Posterior pole view, 50-degree field of view, camera: Topcon TRC-50DX:
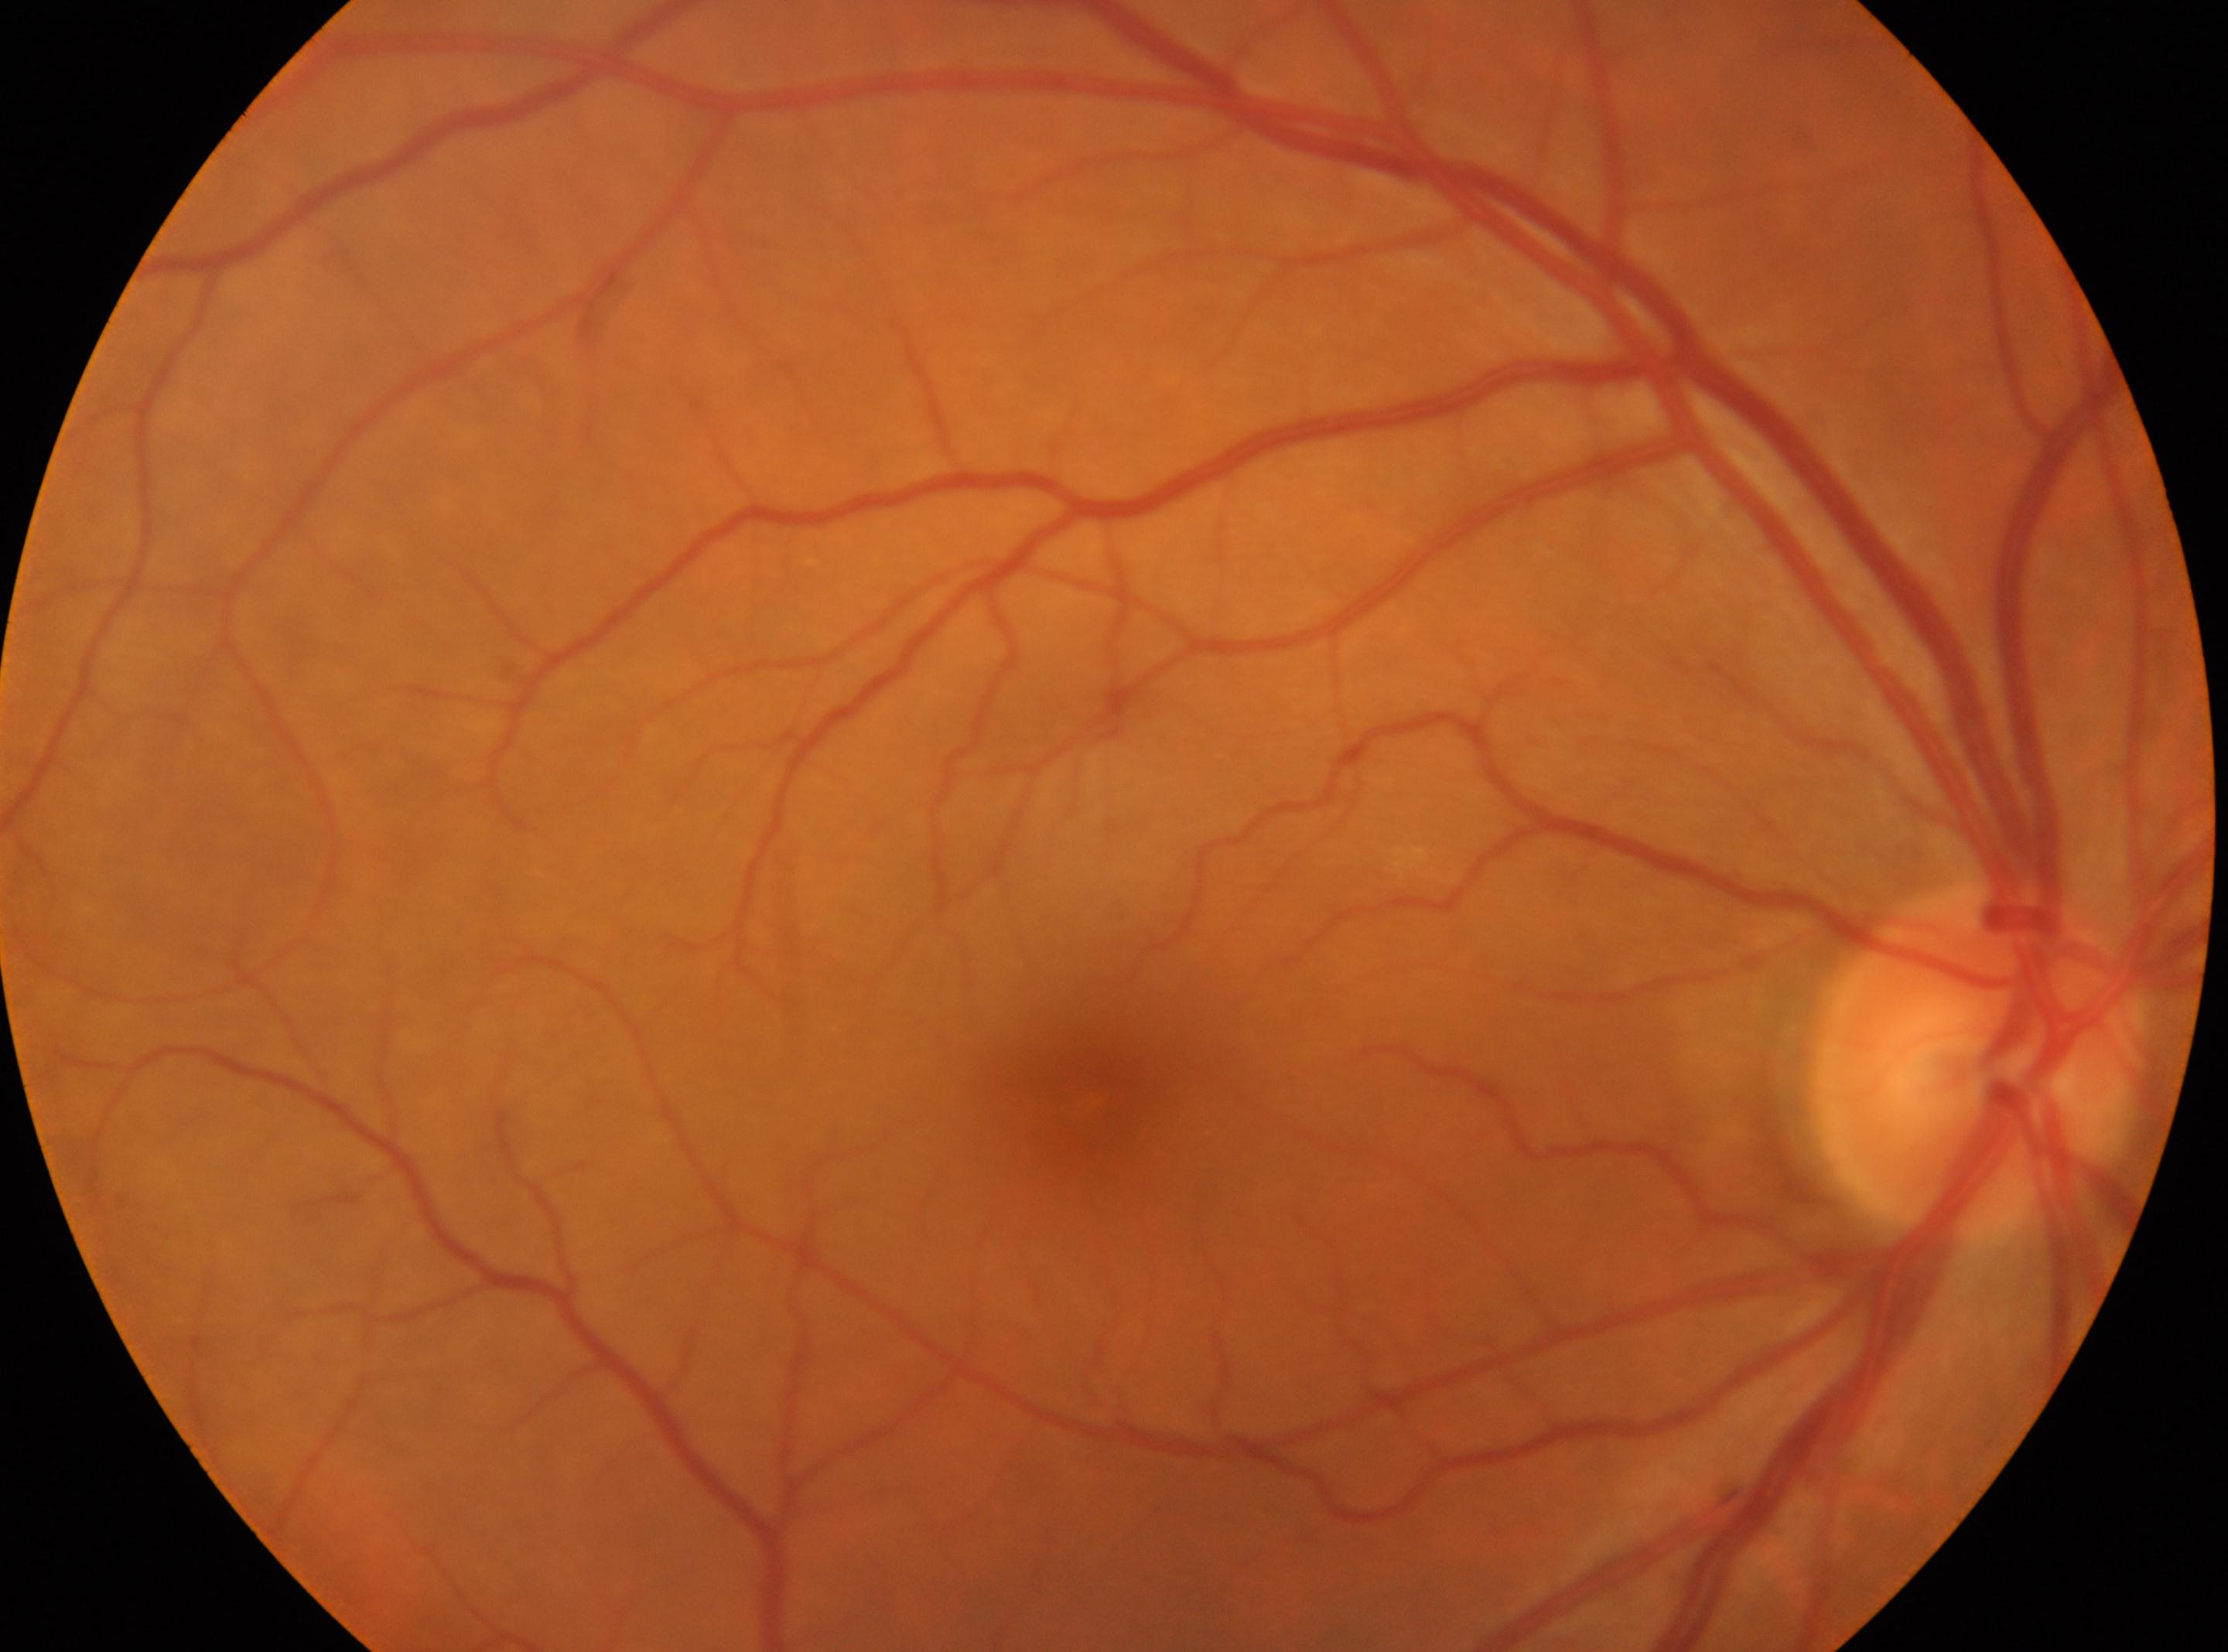
No diabetic retinopathy identified. The image shows the oculus dexter. Macula center located at (x: 1095, y: 1100). Diabetic retinopathy (DR) is grade 0 (no apparent retinopathy) — no visible signs of diabetic retinopathy. The optic disc is at (x: 1976, y: 1057).